1659x2212px: 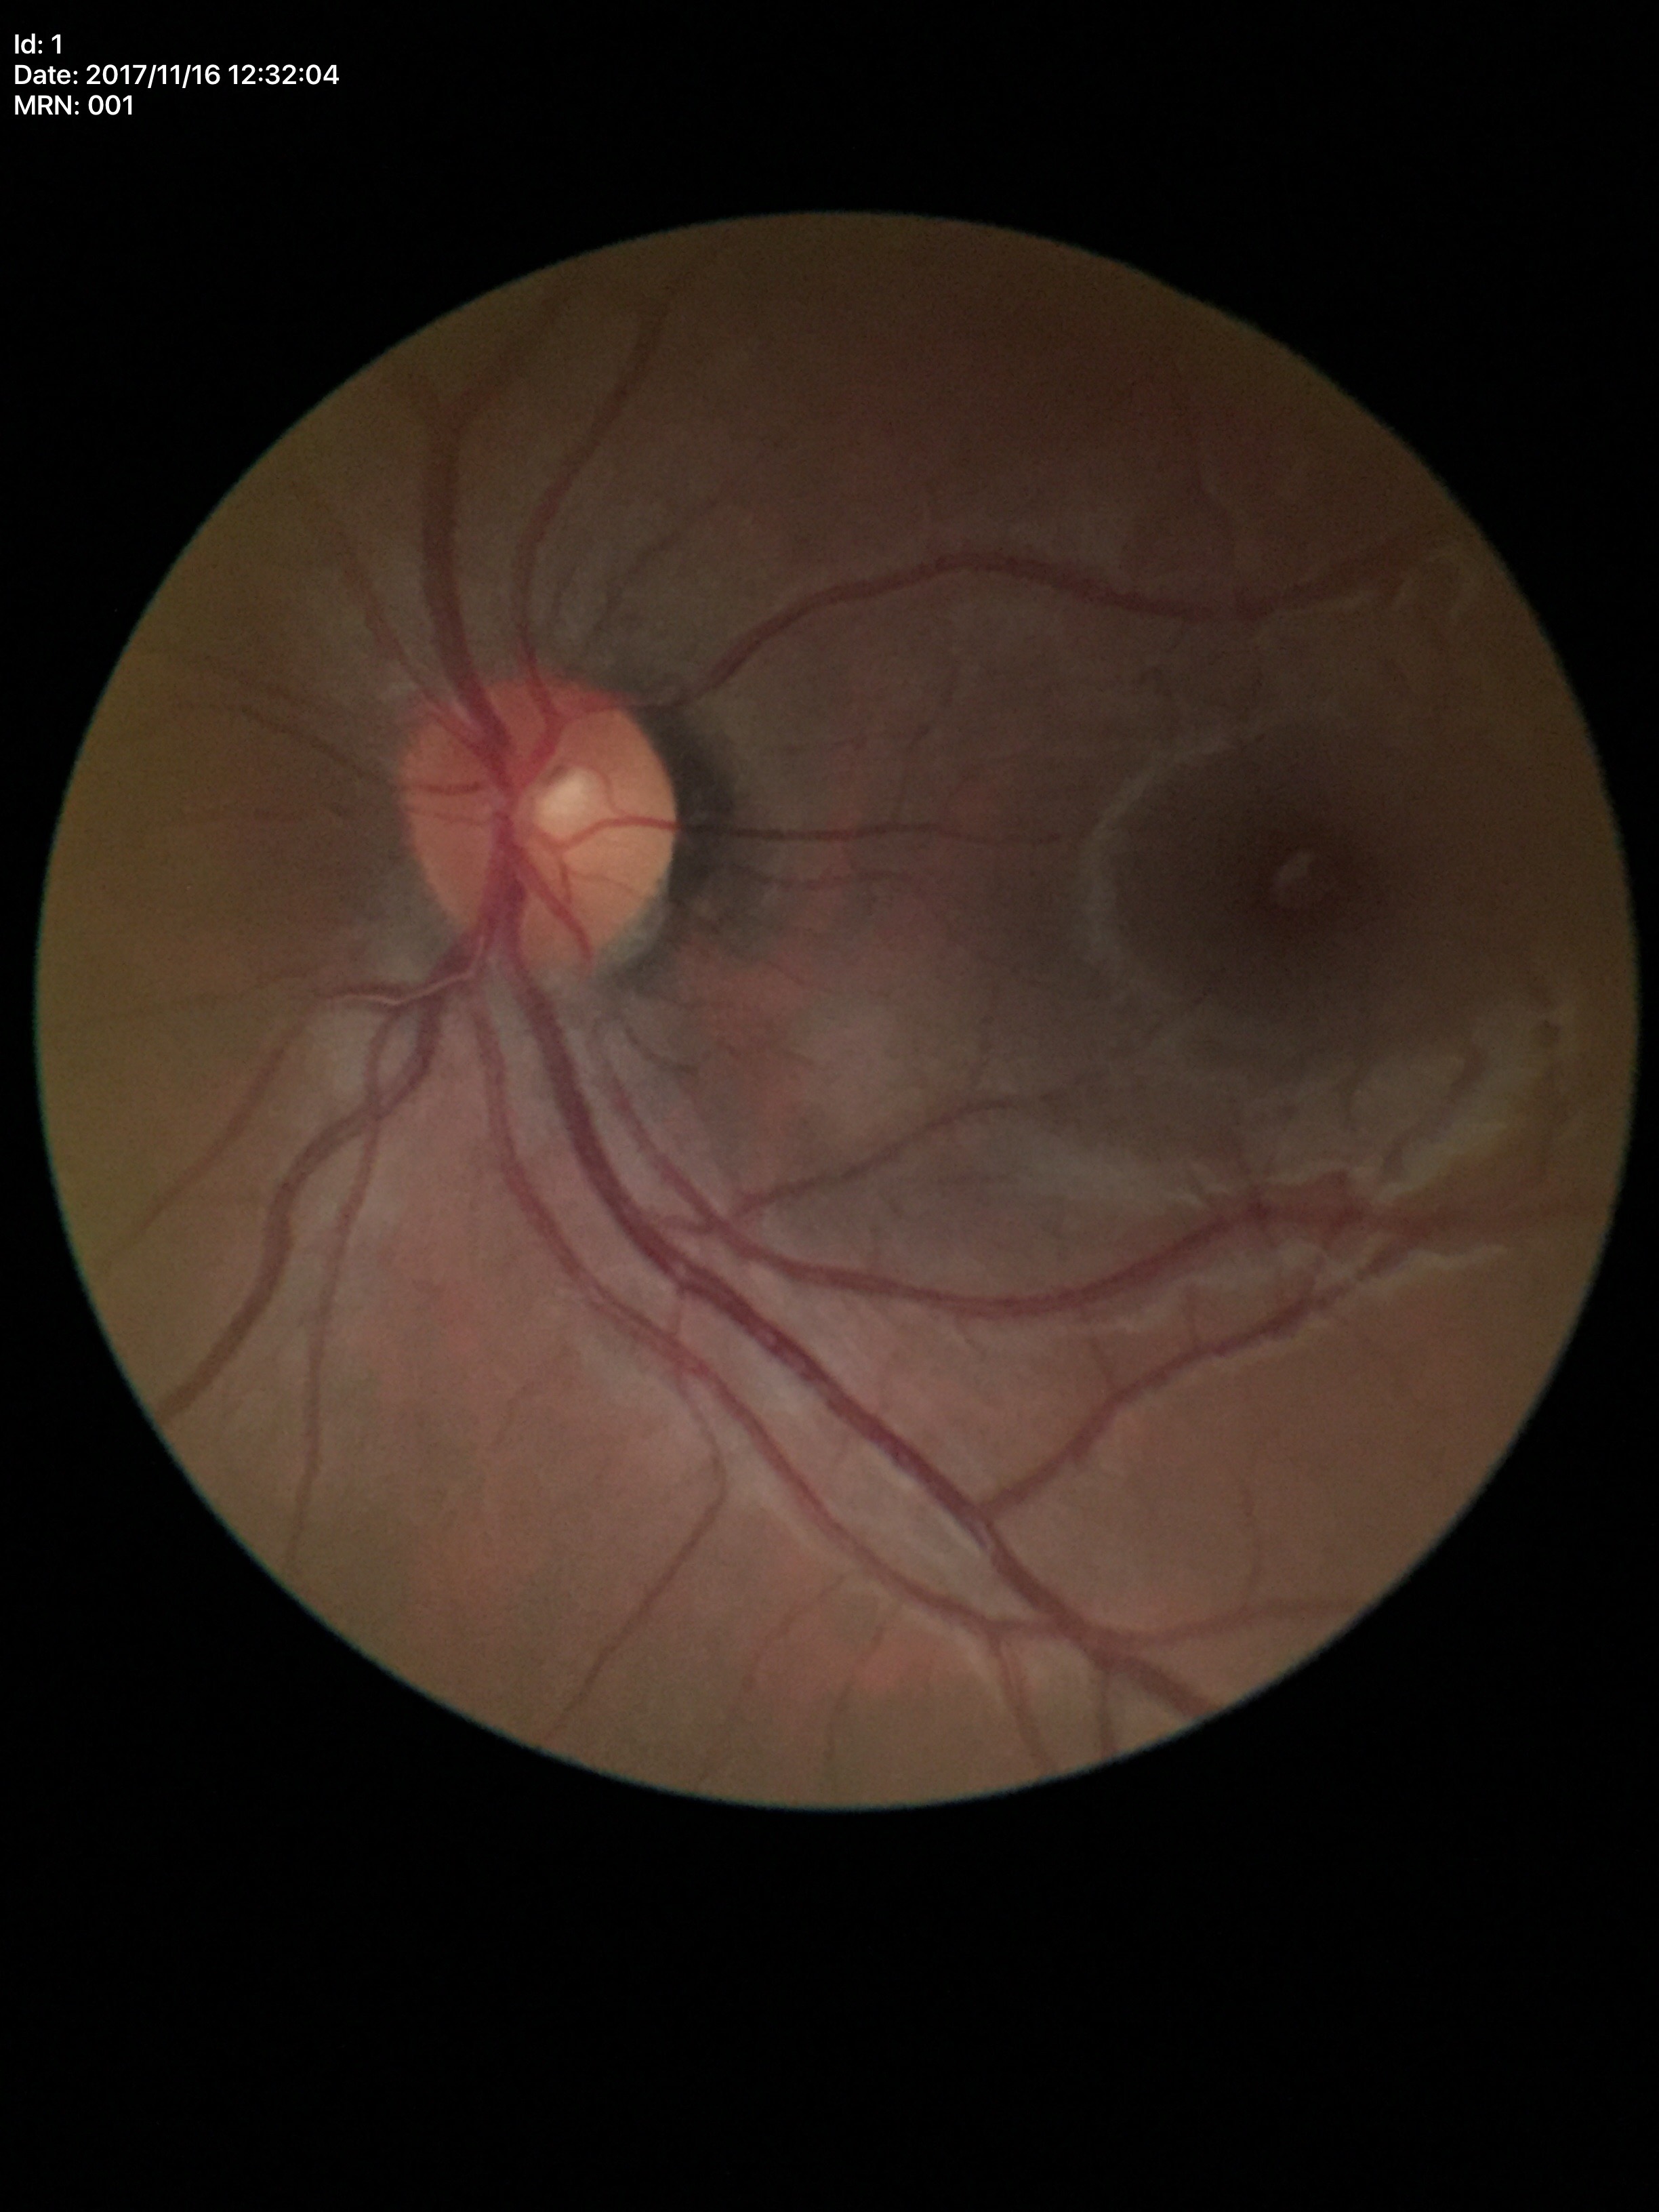
Q: Is there glaucoma suspicion?
A: no suspicious findings (5/5 ophthalmologists in agreement)
Q: What is the vertical cup-to-disc ratio?
A: 0.41